Color fundus photograph; modified Davis grading; without pupil dilation; 848 x 848 pixels: 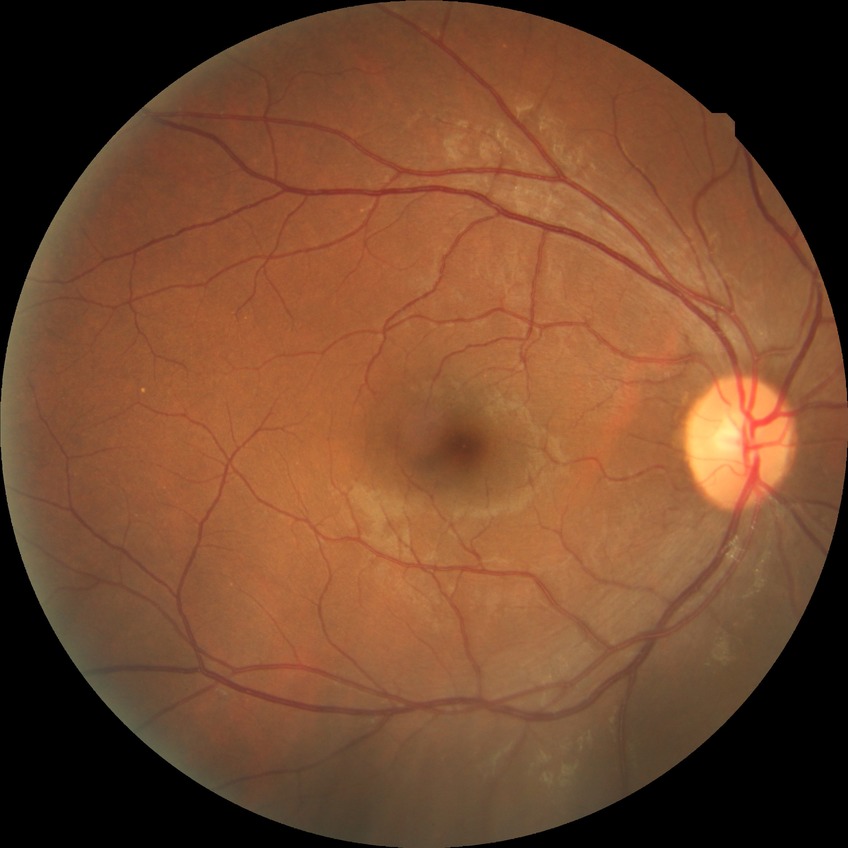 Assessment:
* diabetic retinopathy (DR): no diabetic retinopathy (NDR)